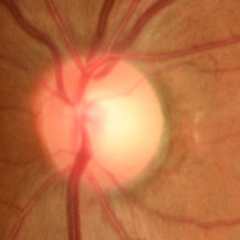

No glaucomatous findings.